45-degree field of view · without pupil dilation · 848 by 848 pixels · camera: NIDEK AFC-230 · posterior pole color fundus photograph — 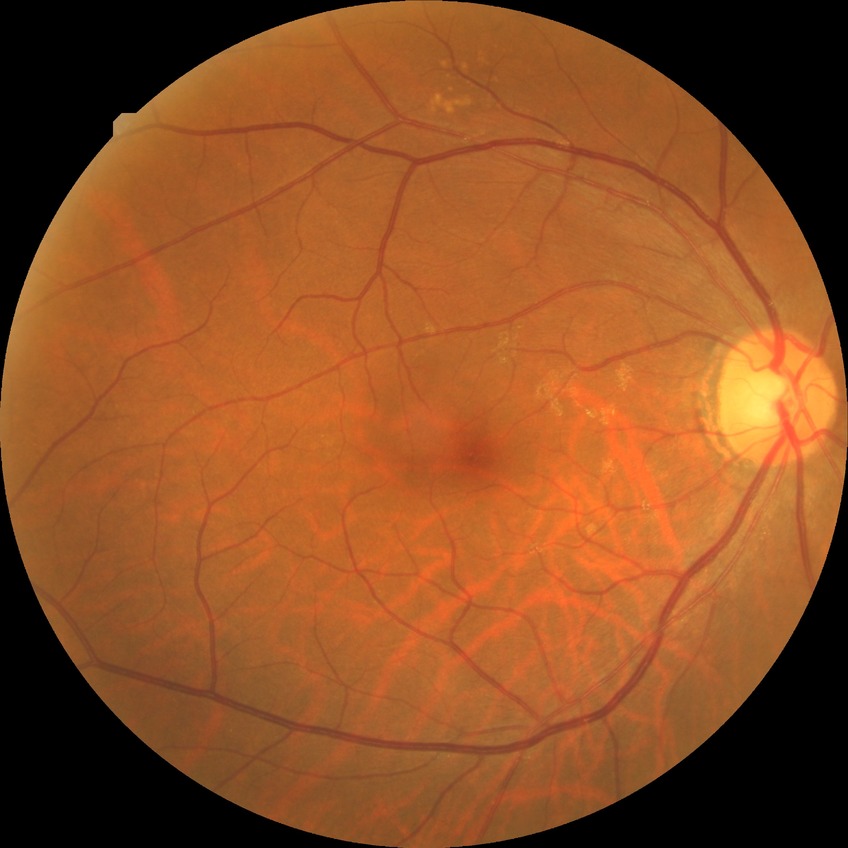 No diabetic retinal disease findings.
Davis grade is NDR.